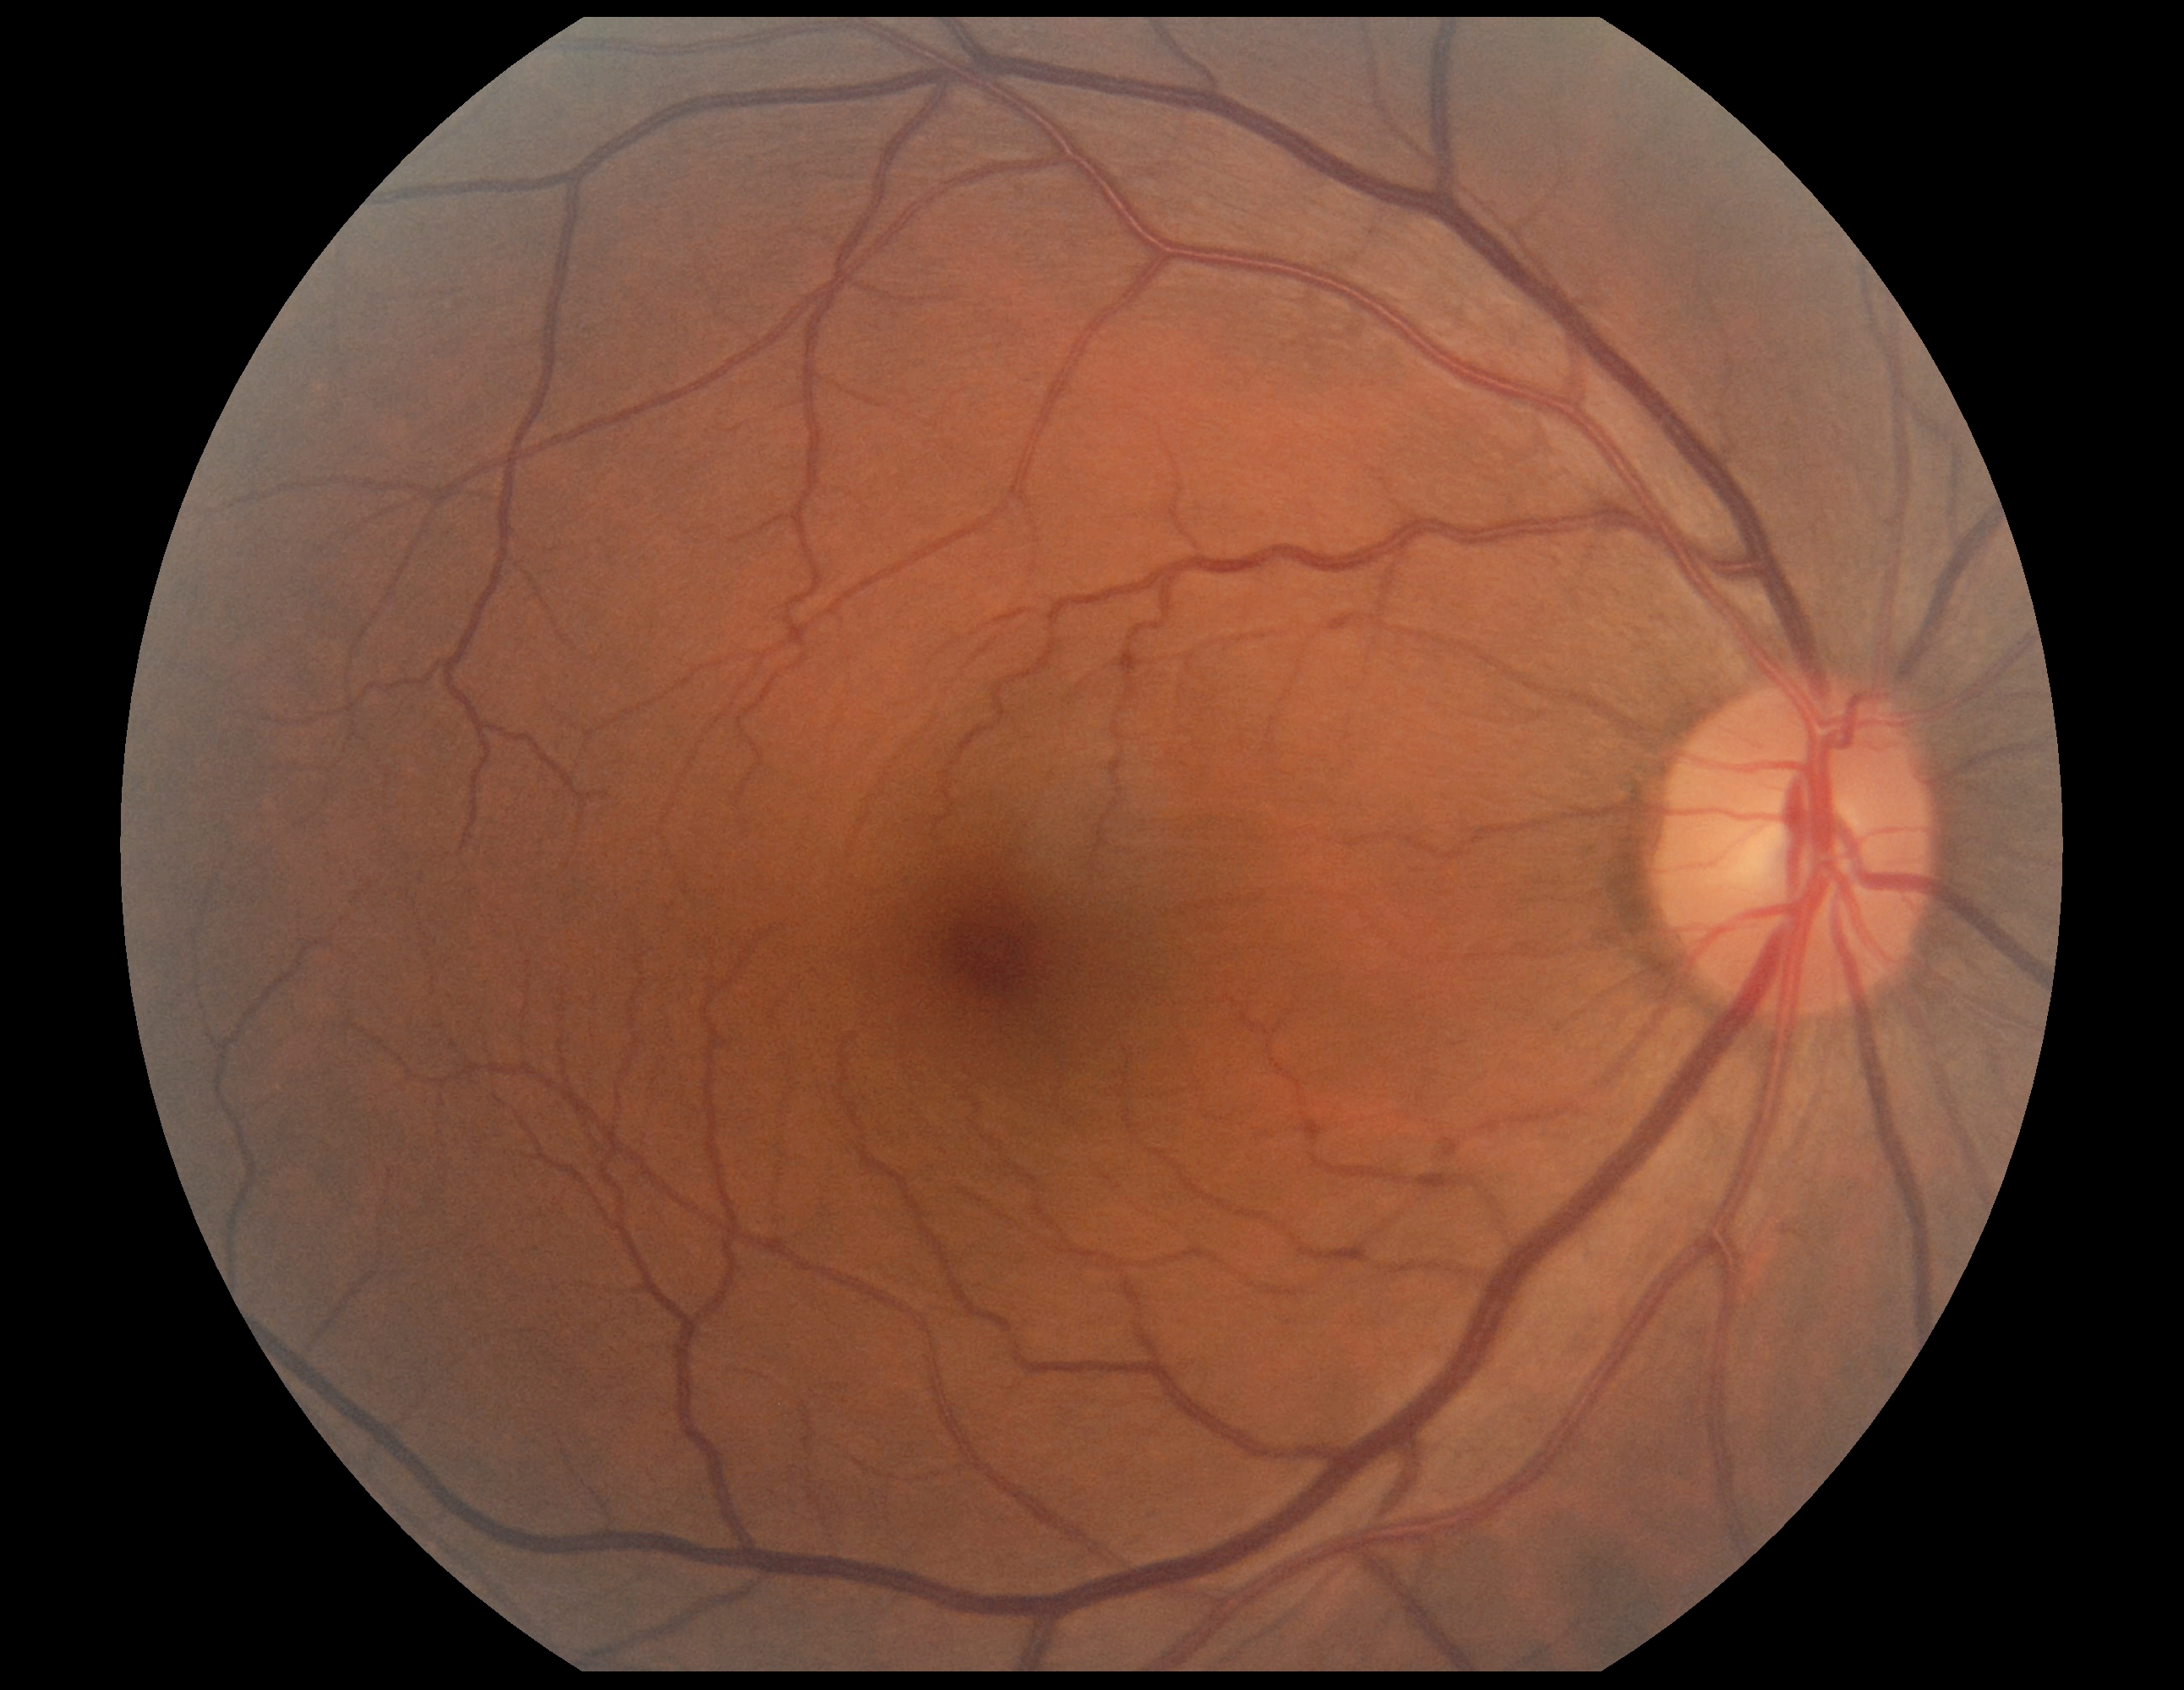
DR stage: grade 0 (no apparent retinopathy). No signs of diabetic retinopathy.